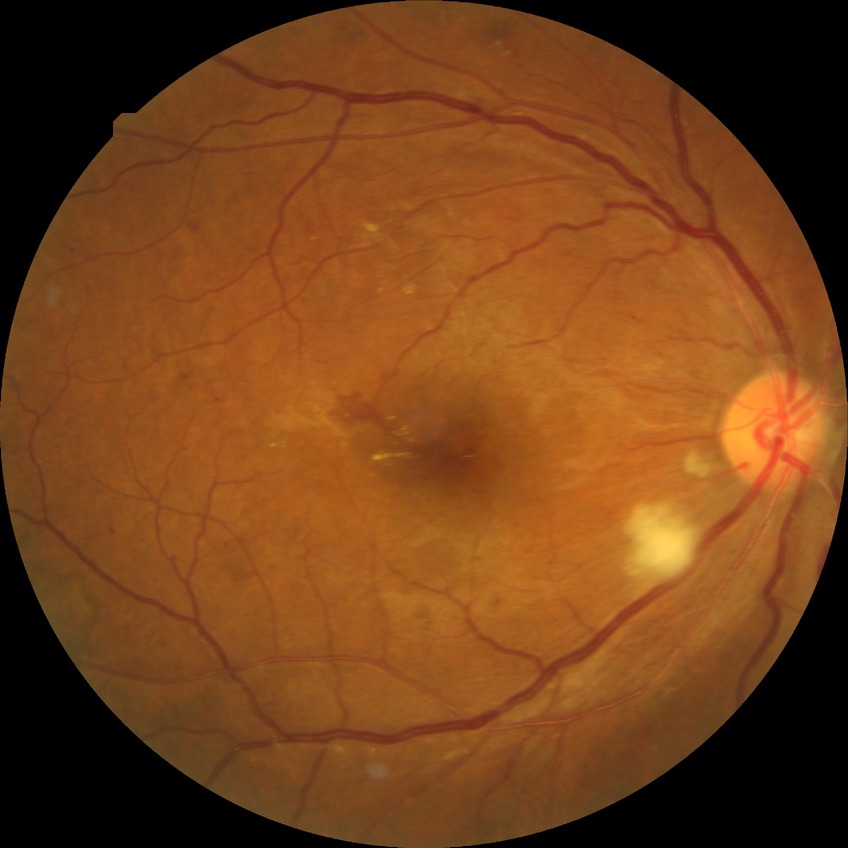
Diabetic retinopathy (DR): PPDR (pre-proliferative diabetic retinopathy).
Disease class: non-proliferative diabetic retinopathy.